Wide-field fundus photograph of an infant — 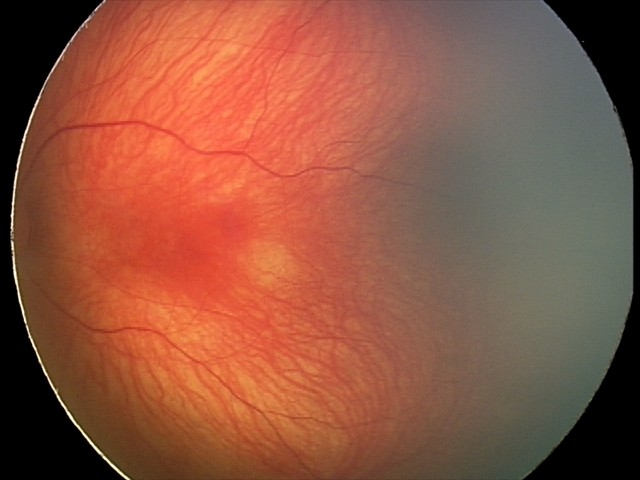
Screening examination consistent with retinal hemorrhages.